Acquired with a NIDEK AFC-230. No pharmacologic dilation. Modified Davis classification. 848x848. Color fundus image. FOV: 45 degrees:
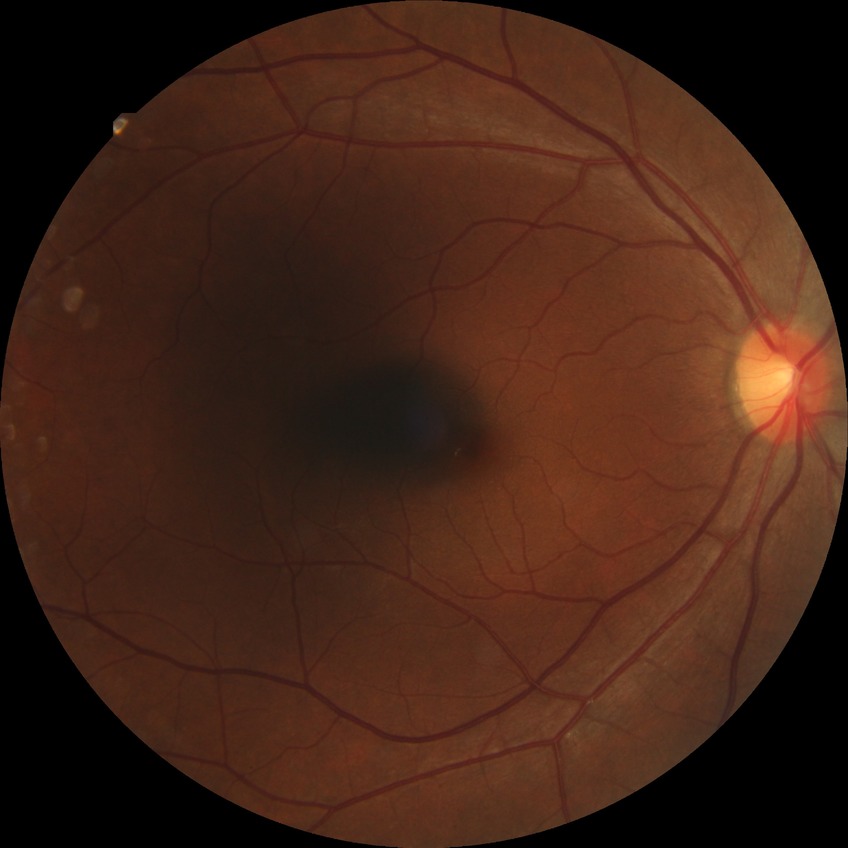 {"davis_grade": "NDR", "dr_impression": "no signs of DR"}